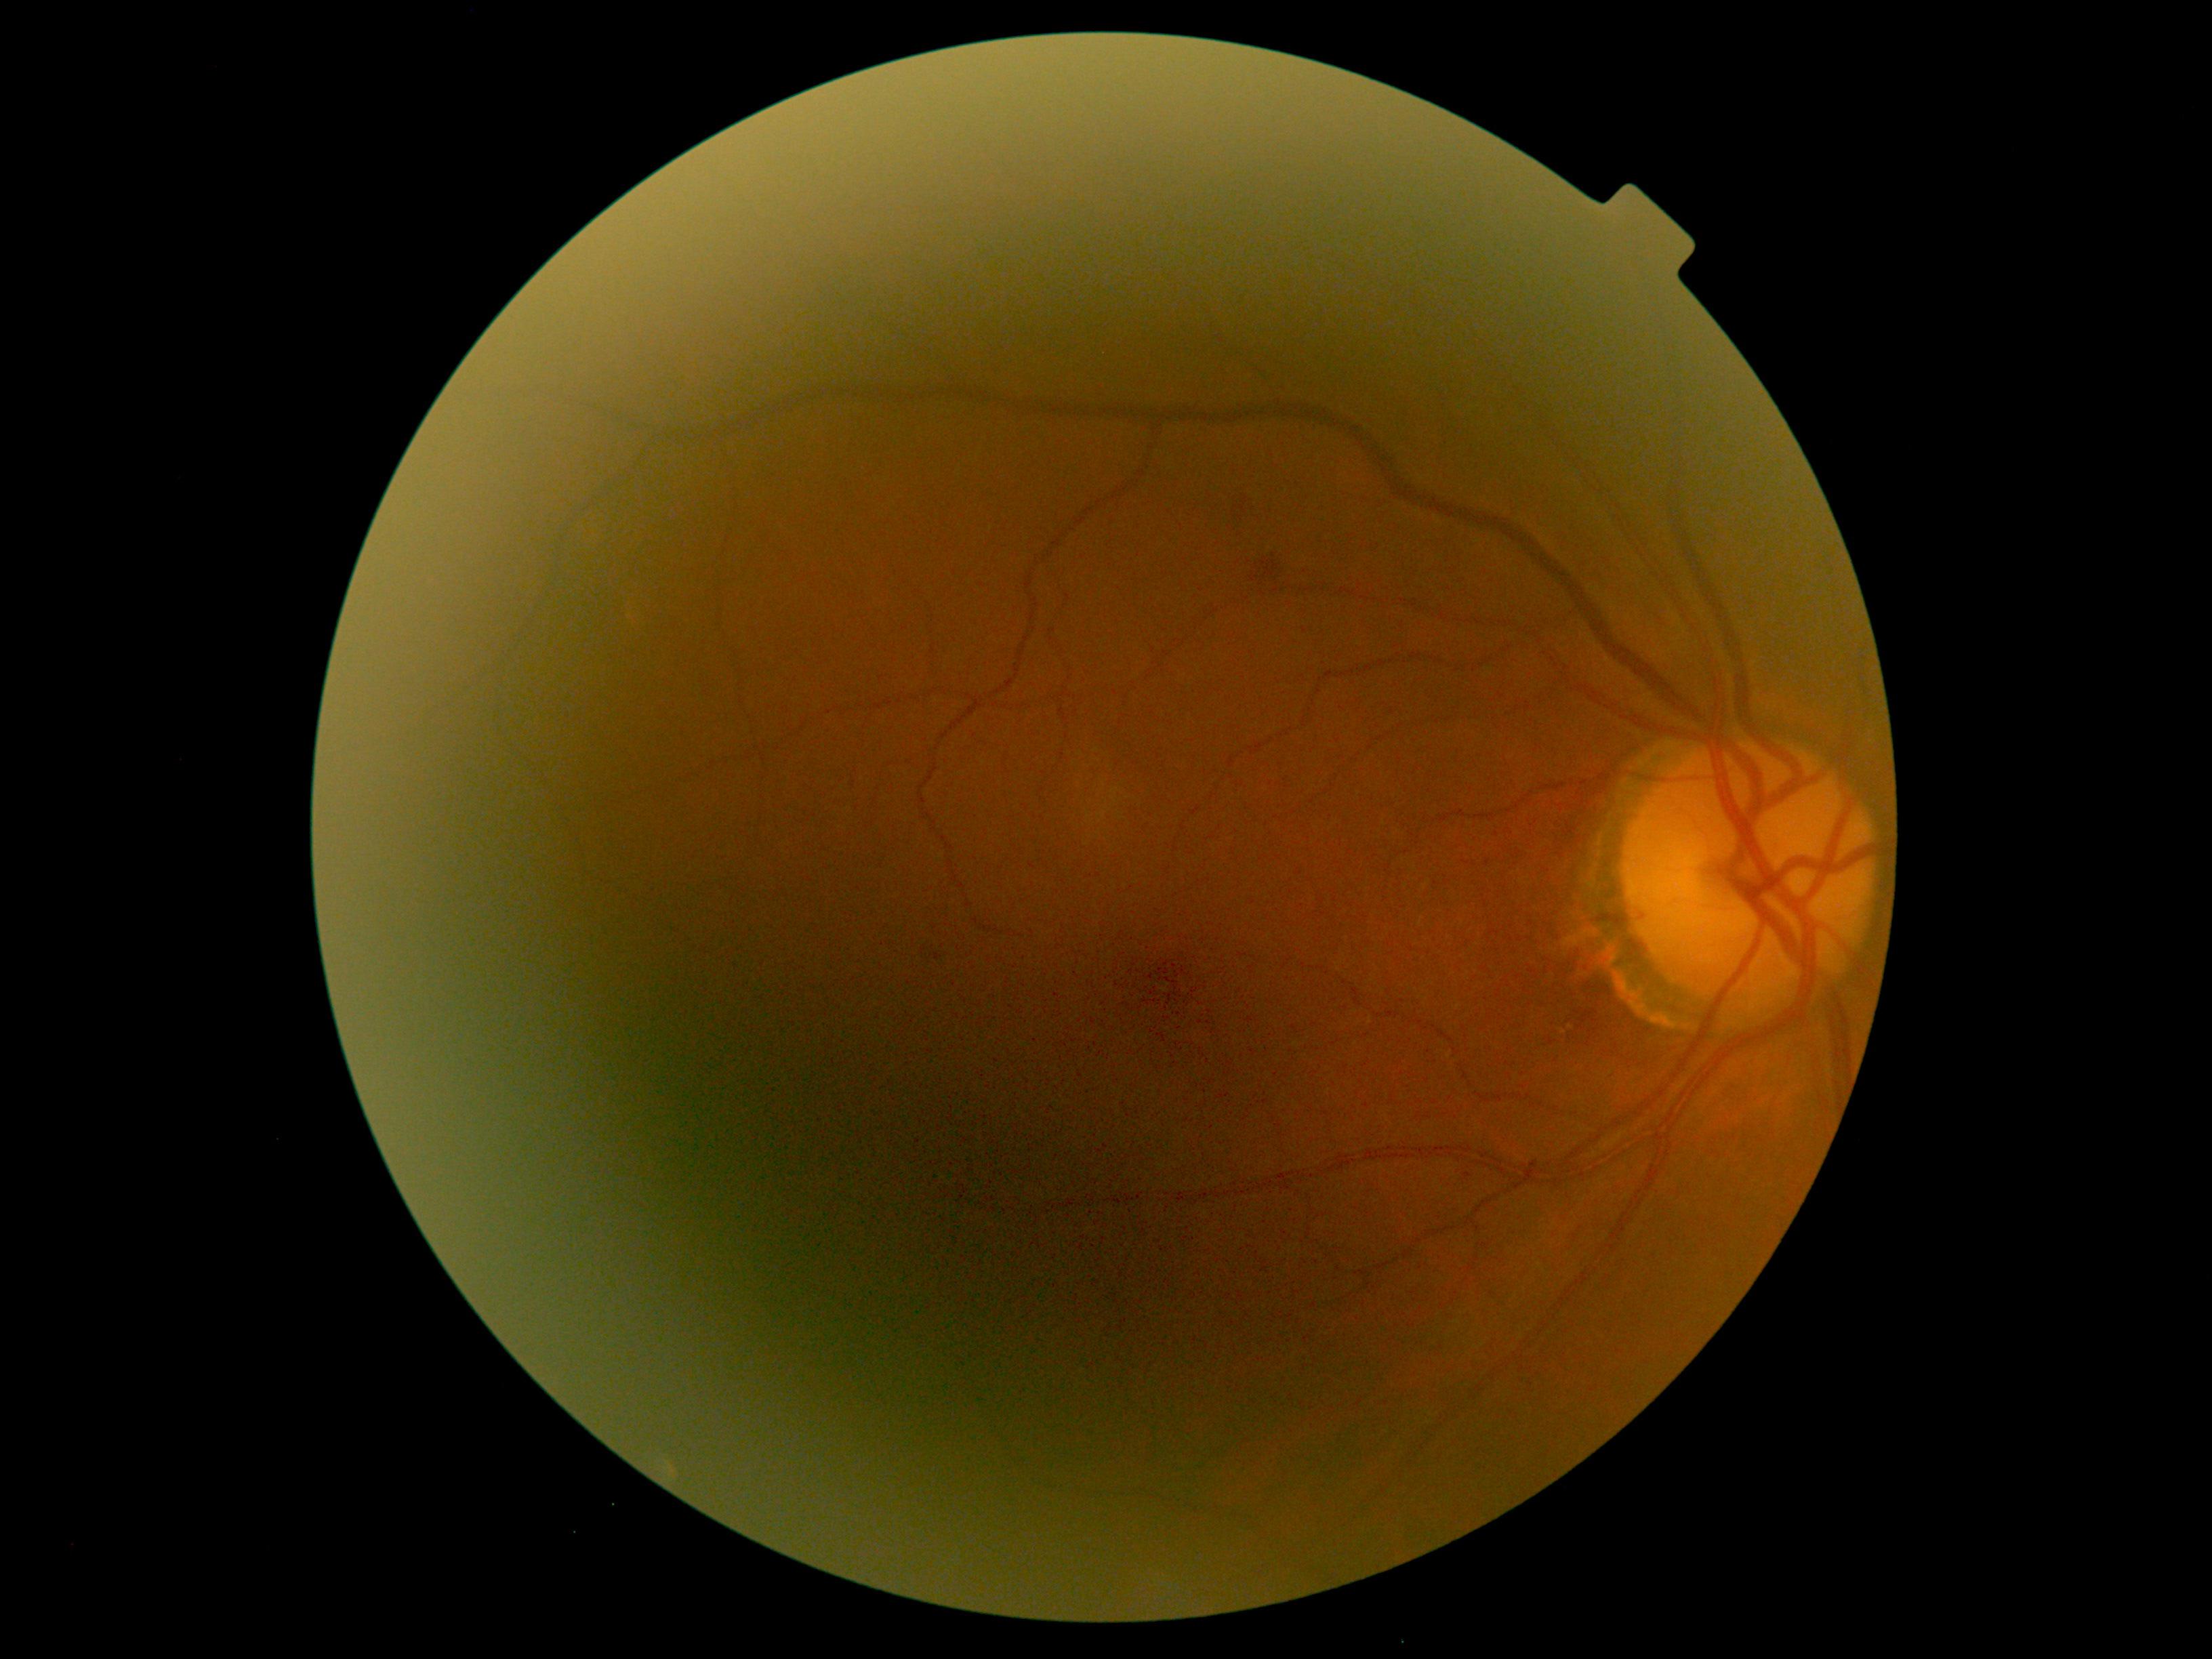
Disease class: non-proliferative diabetic retinopathy. Diabetic retinopathy: moderate non-proliferative diabetic retinopathy (grade 2).